2212x1659px. Fundus photo.
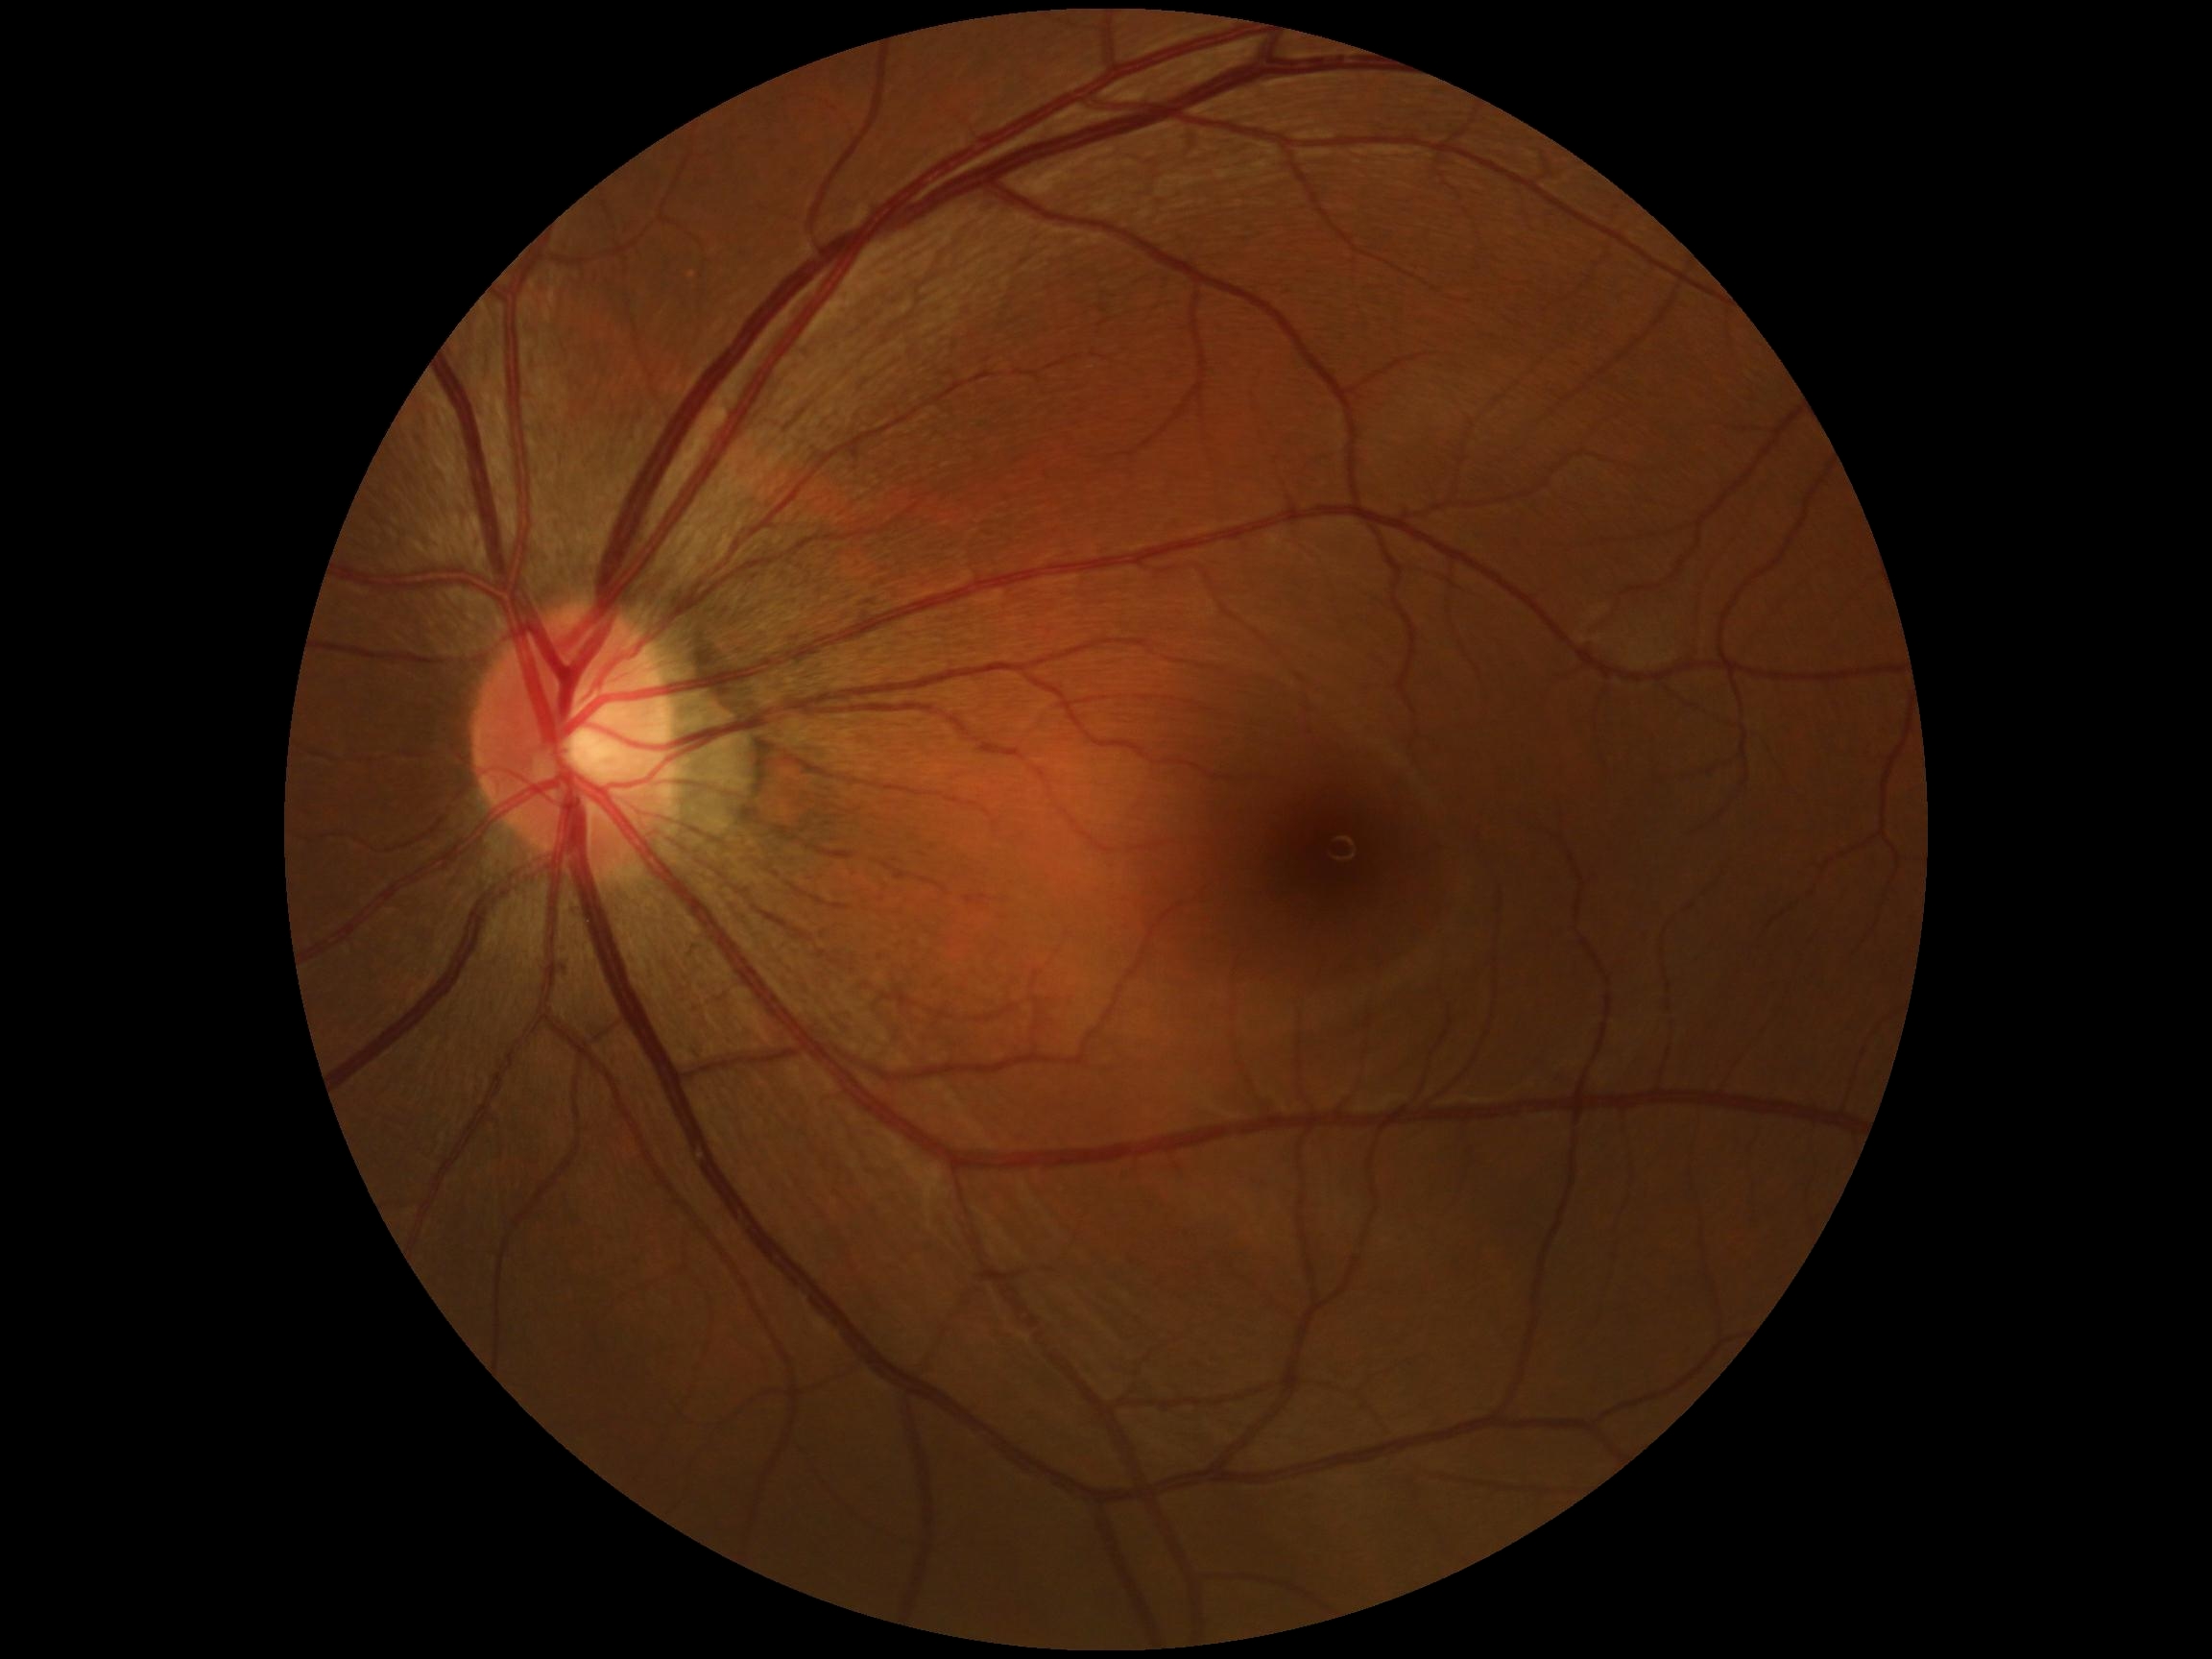
DR impression=no apparent DR, retinopathy grade=no apparent diabetic retinopathy (0).